Davis DR grading
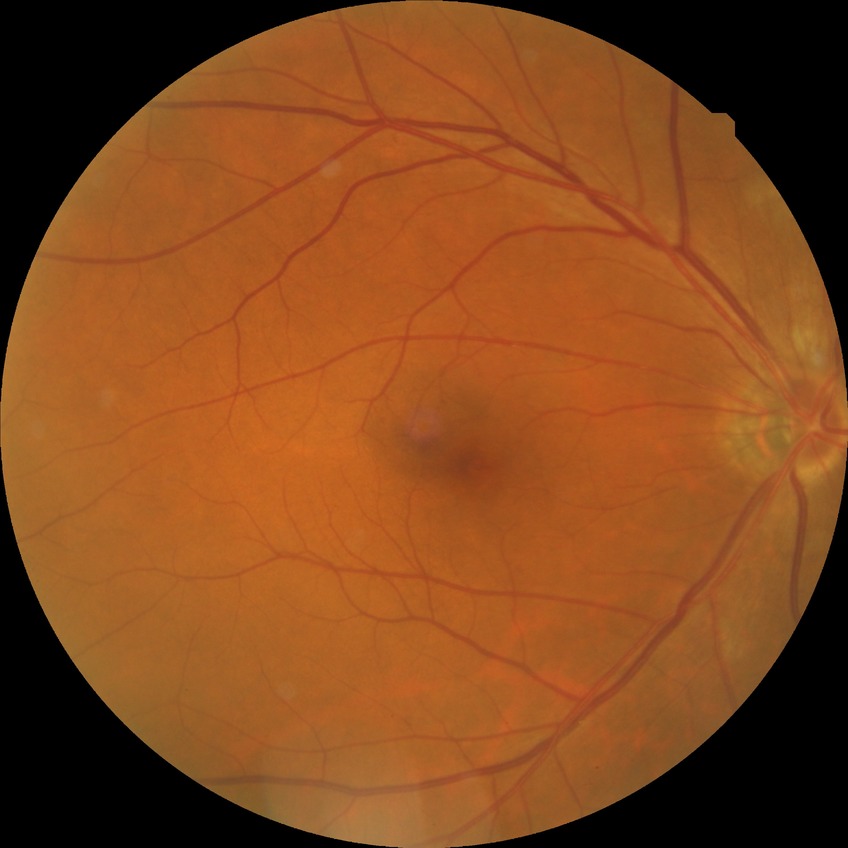

Davis grading: no diabetic retinopathy.